NIDEK AFC-230. No pharmacologic dilation. DR severity per modified Davis staging: 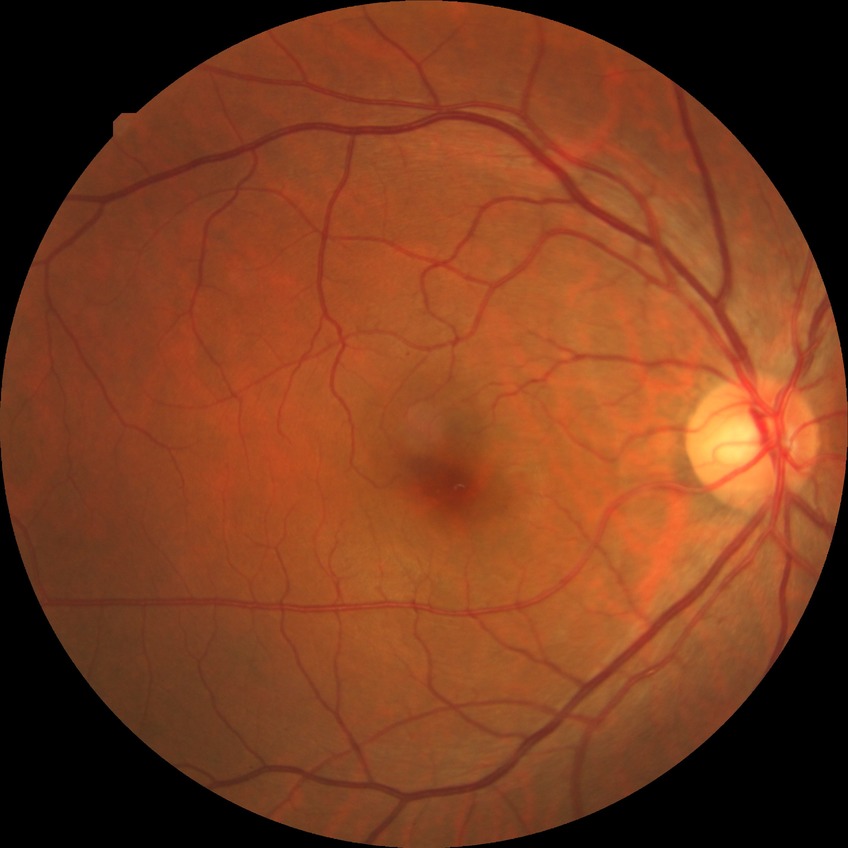 Modified Davis grade is SDR.